Acquired with a NIDEK AFC-230
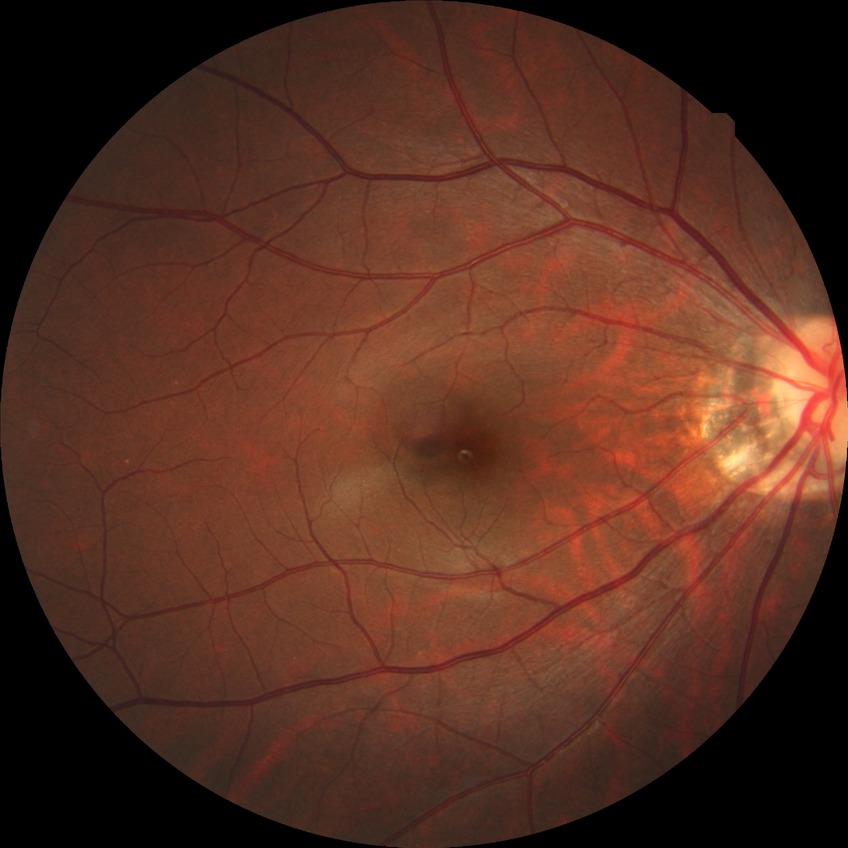 modified Davis classification = no diabetic retinopathy.